Image size 2352x1568, FOV: 45 degrees.
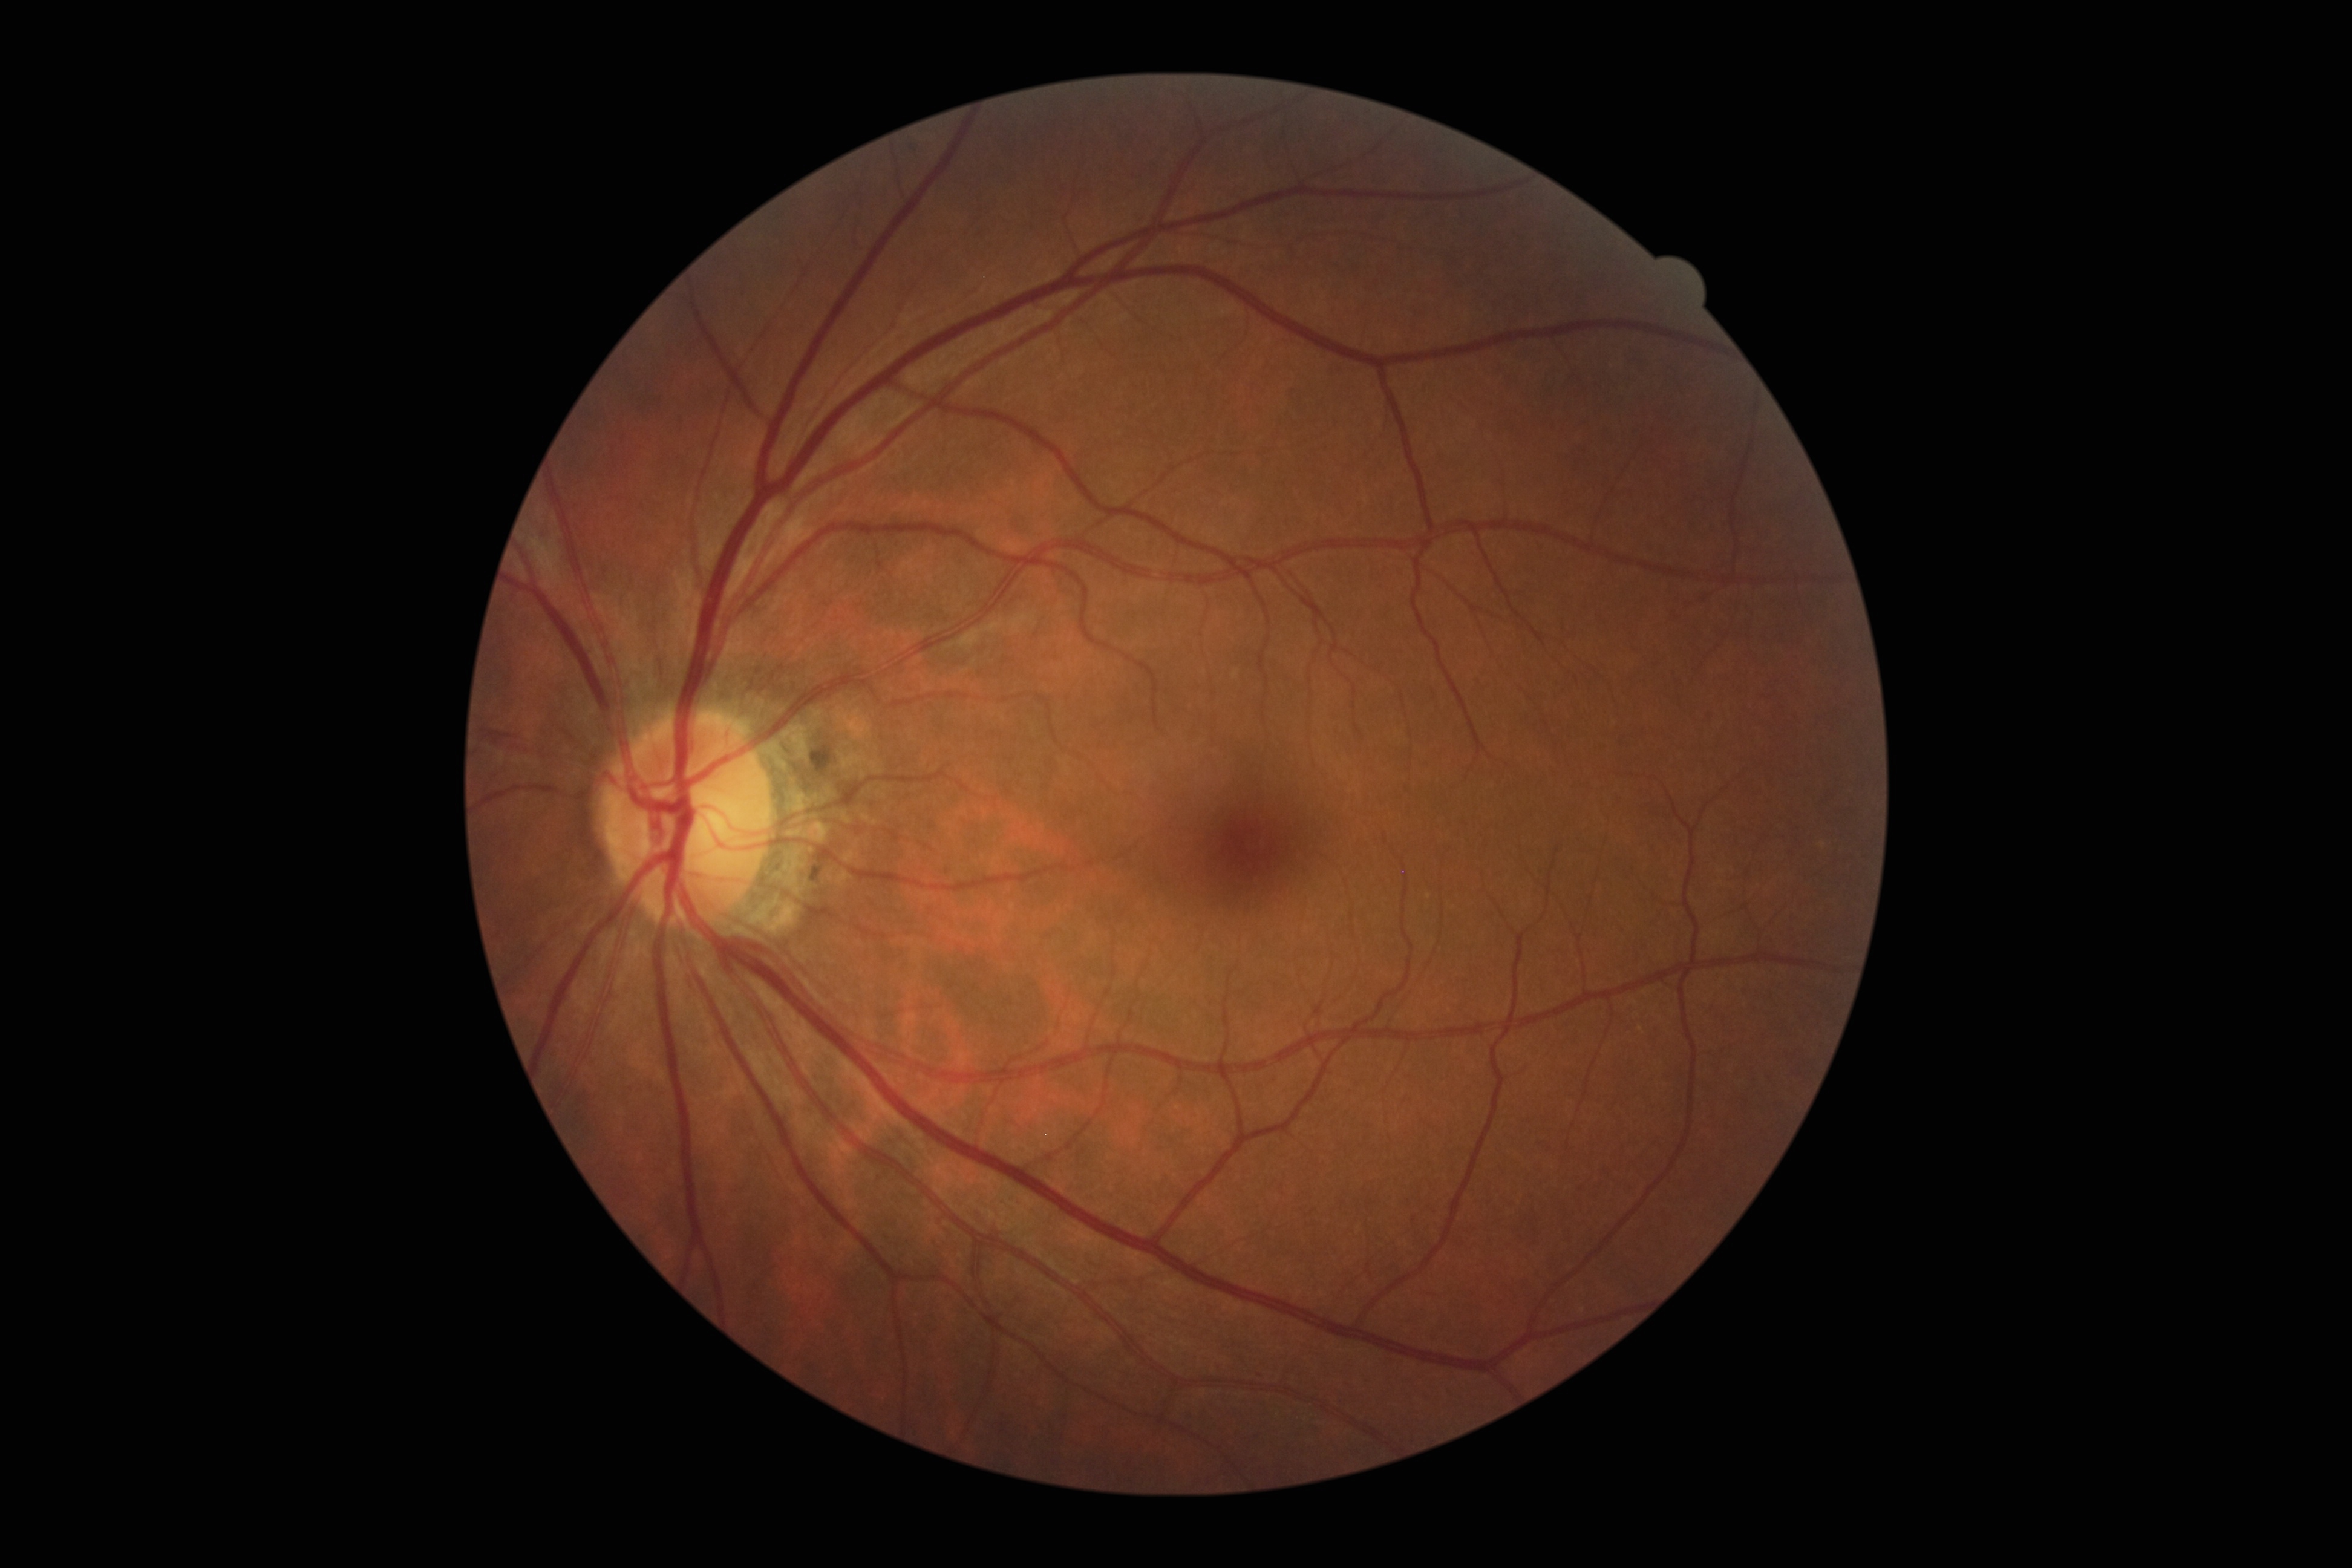

DR class@non-proliferative diabetic retinopathy; diabetic retinopathy grade@moderate non-proliferative diabetic retinopathy (2).